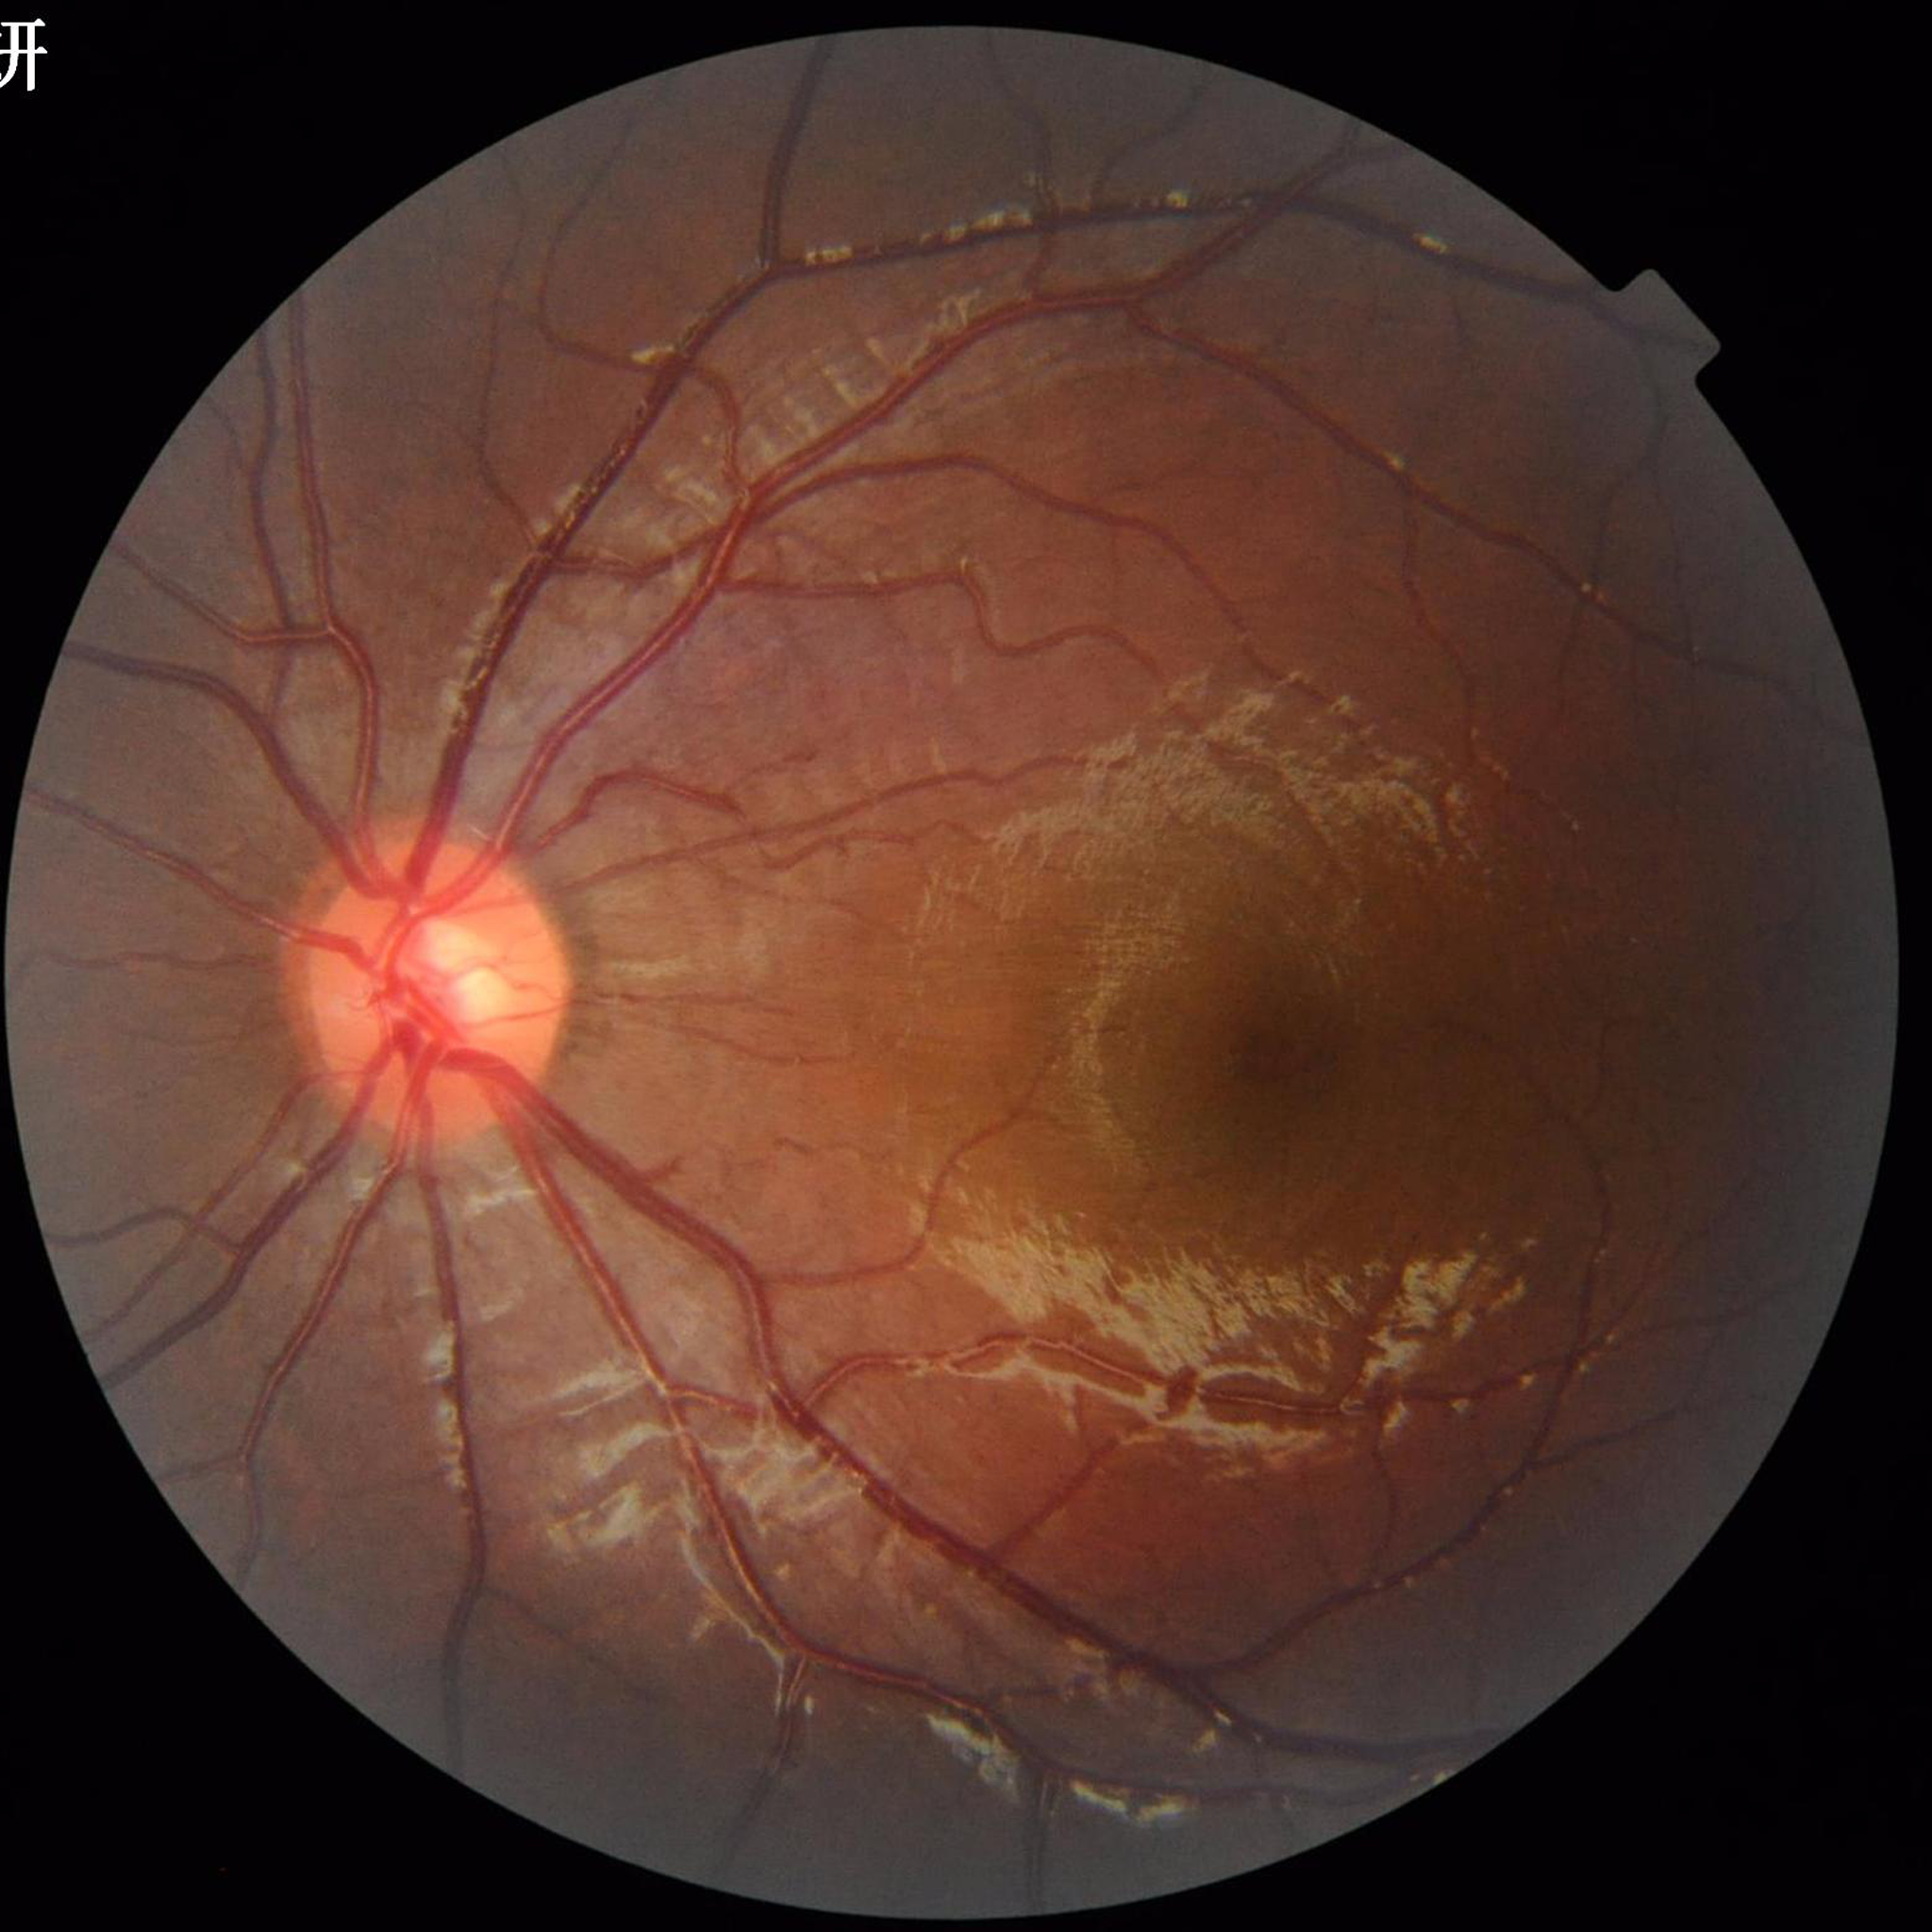 Impression: no AMD, DR, or glaucoma.